CFP:
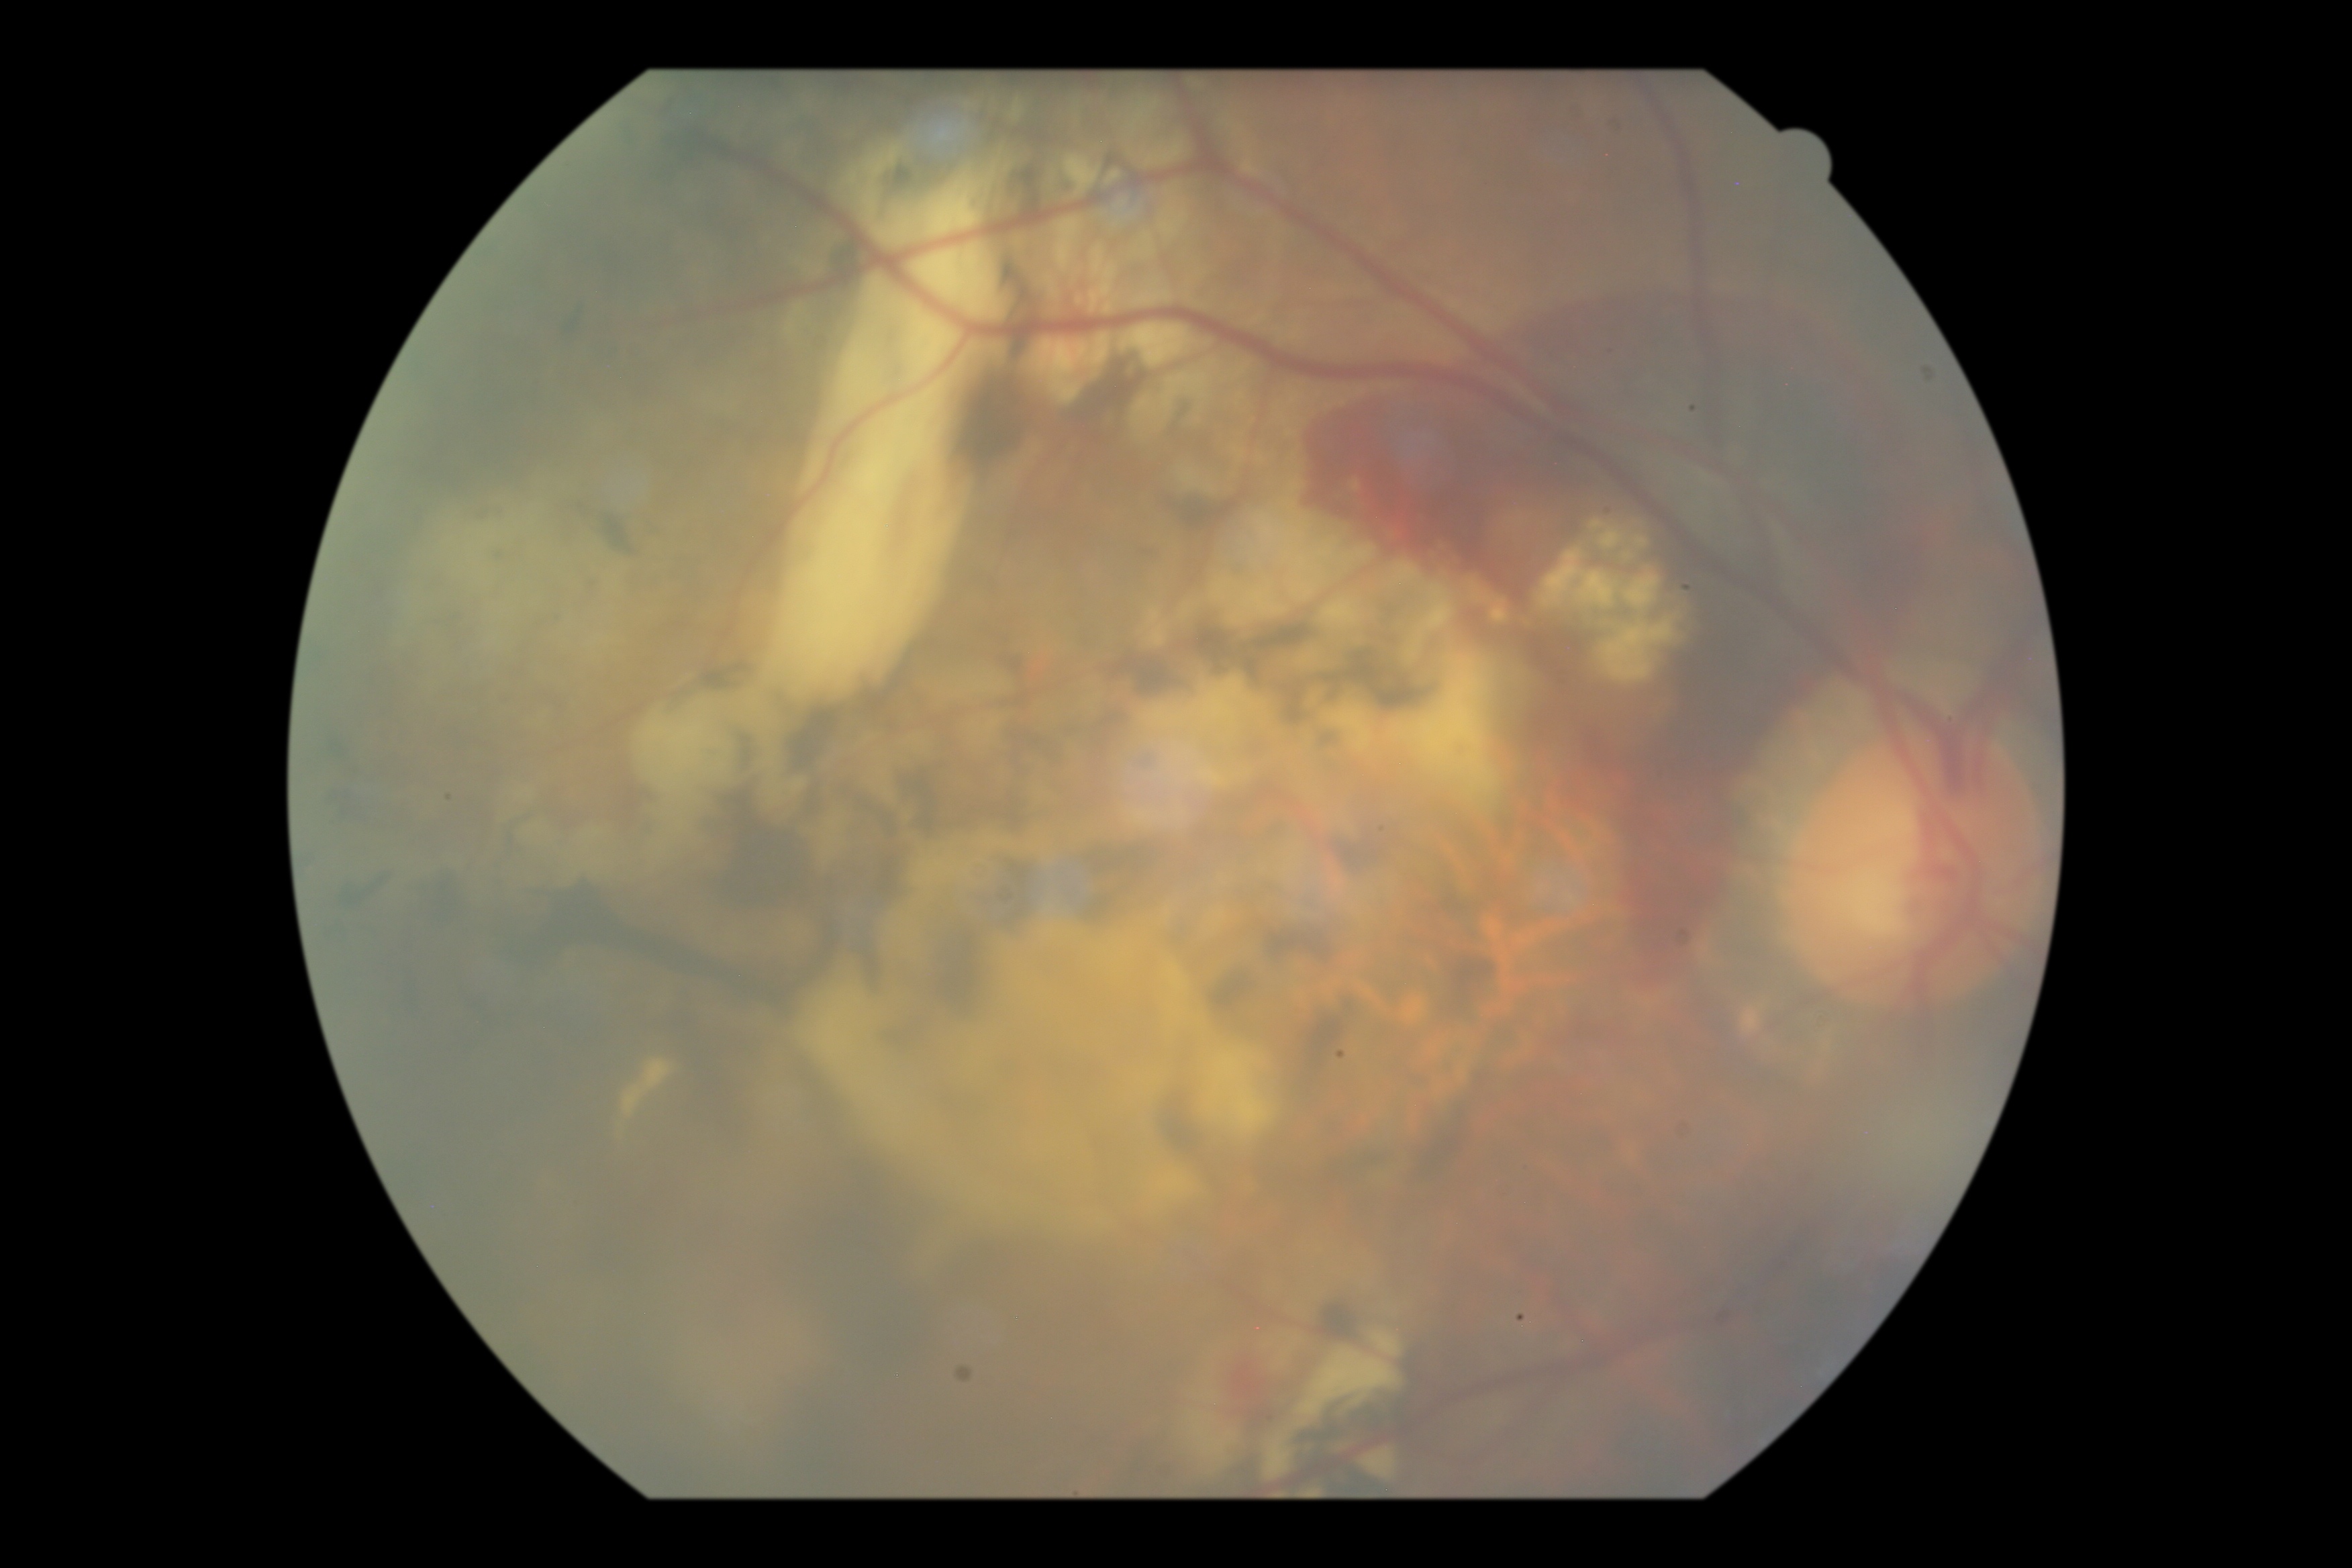
  dr_grade: 4